Acquired with a Topcon TRC-50DX · CFP · 2228 x 1652 pixels · mydriatic (tropicamide and phenylephrine).
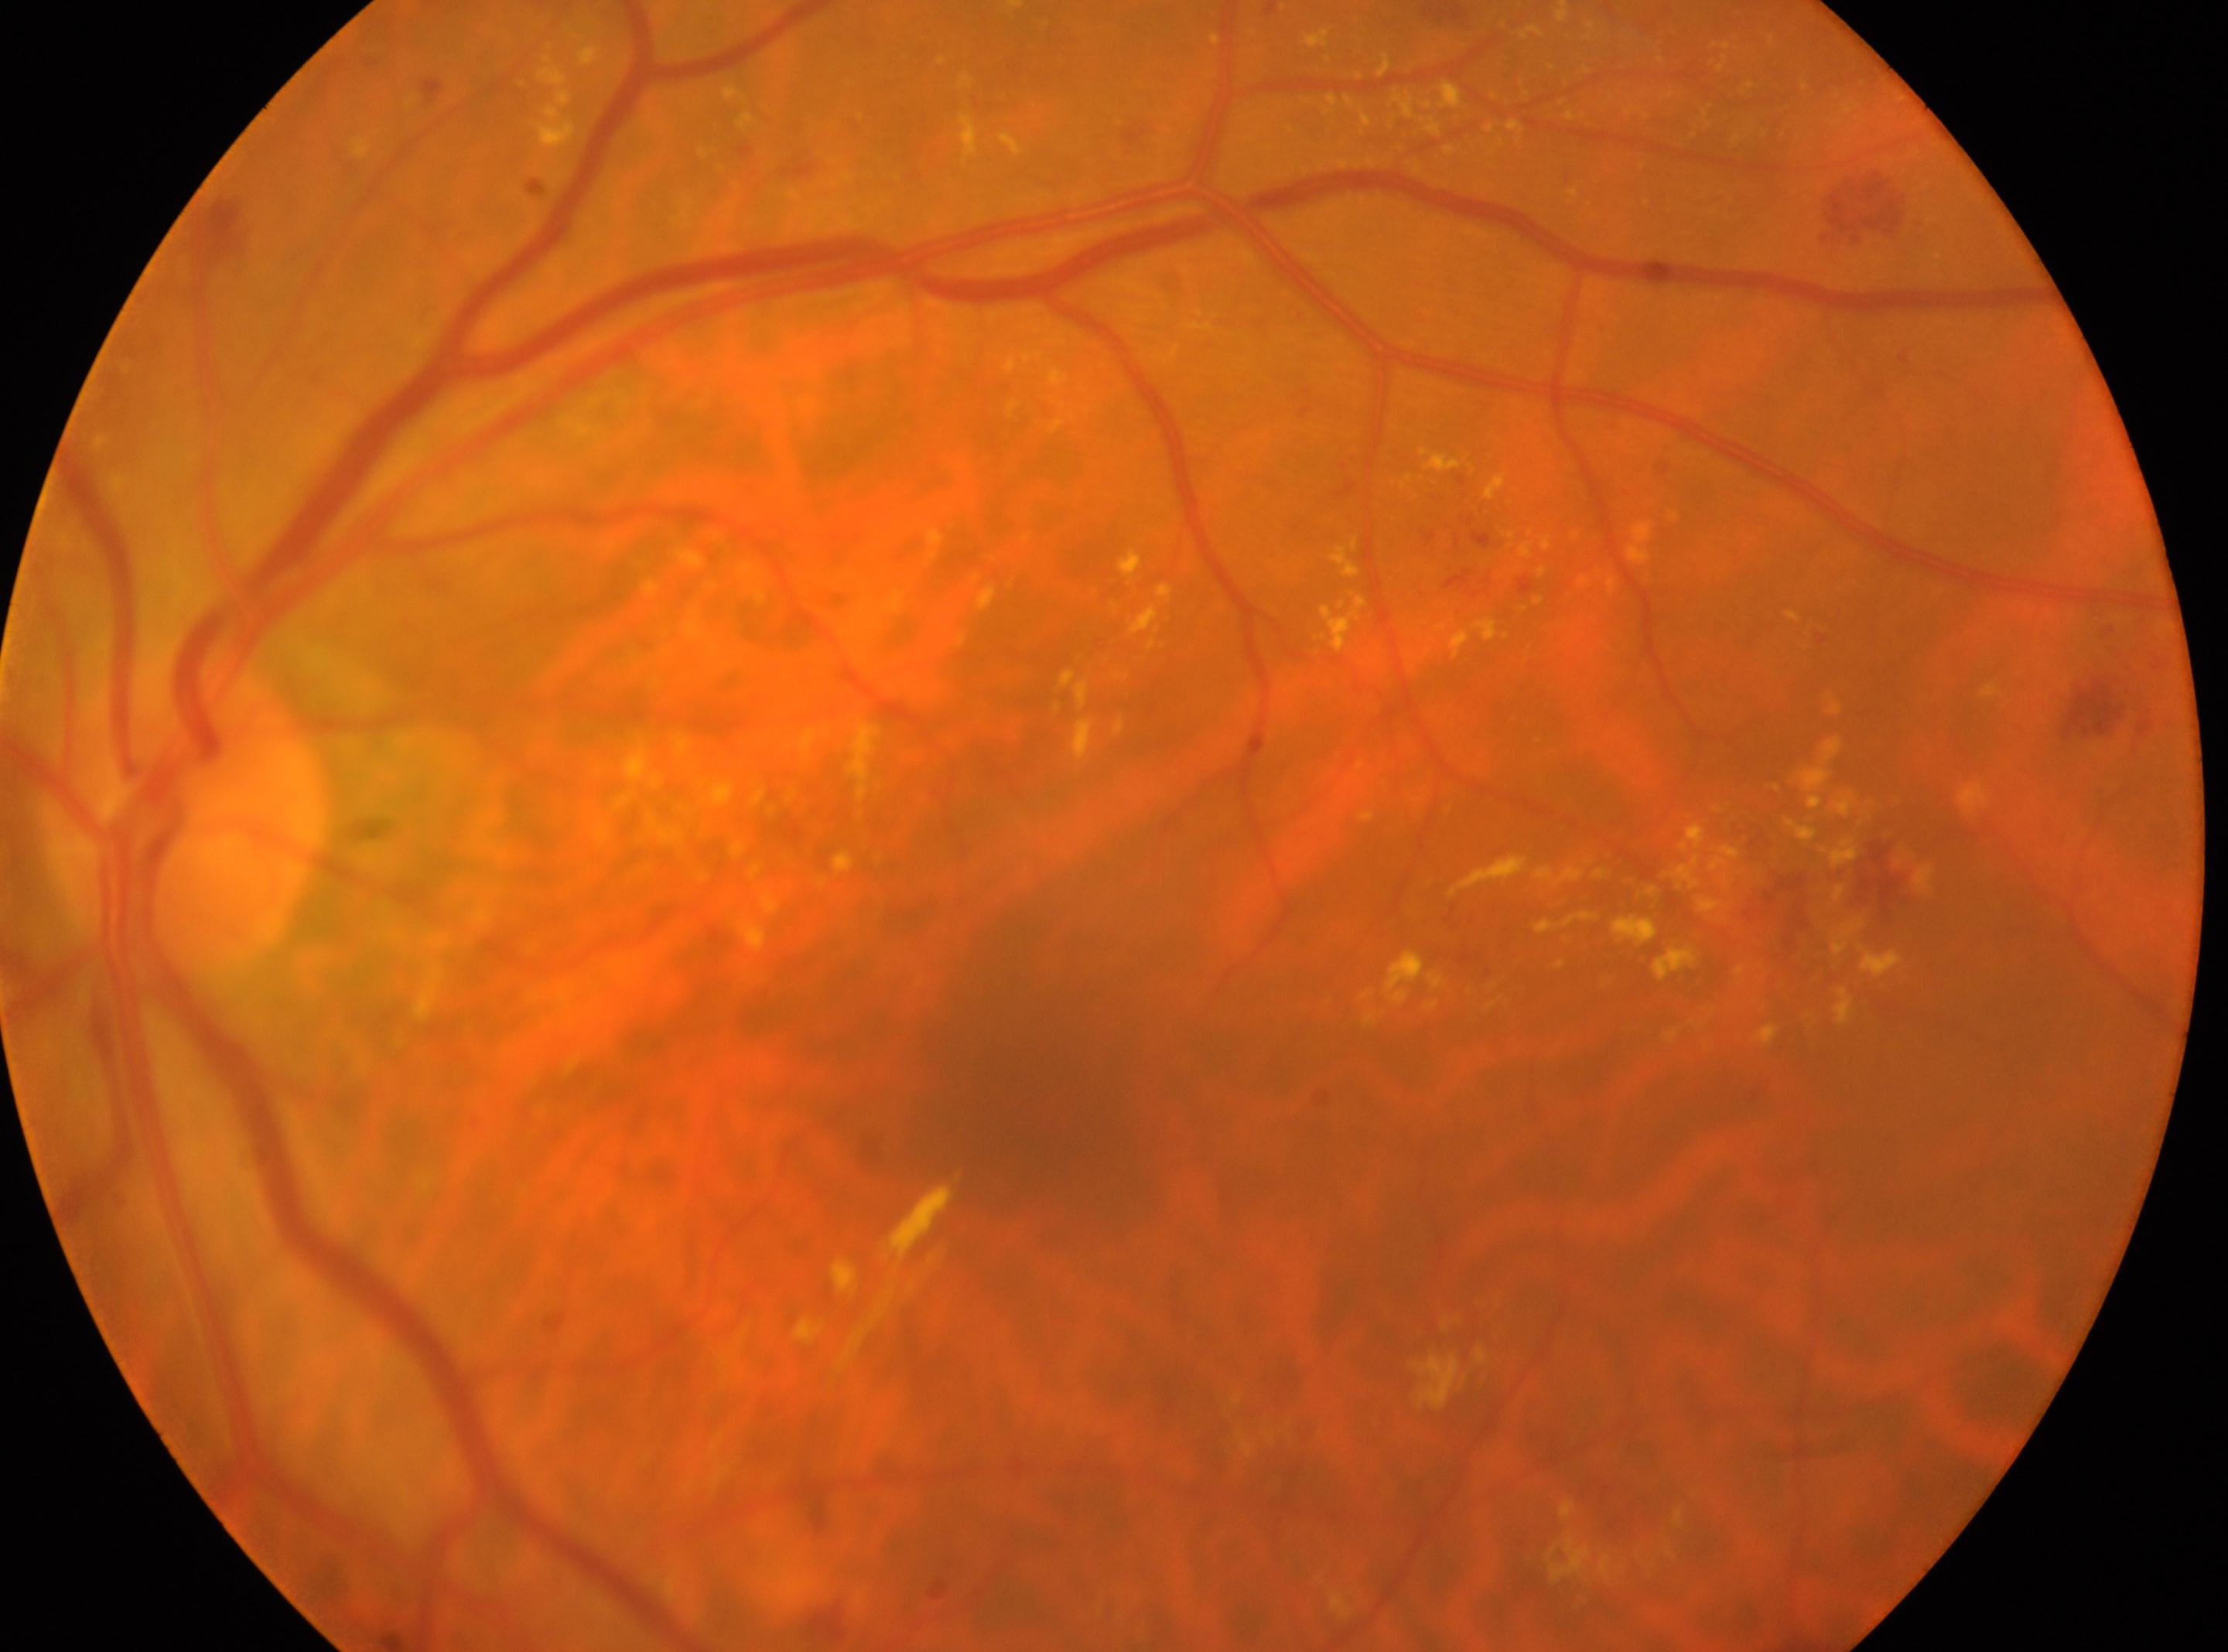
  dr_grade: 2 — more than just microaneurysms but less than severe NPDR
  fovea: x=1035, y=1114
  eye: left
  optic_disc: x=183, y=821